2352x1568px. CFP. 45° field of view.
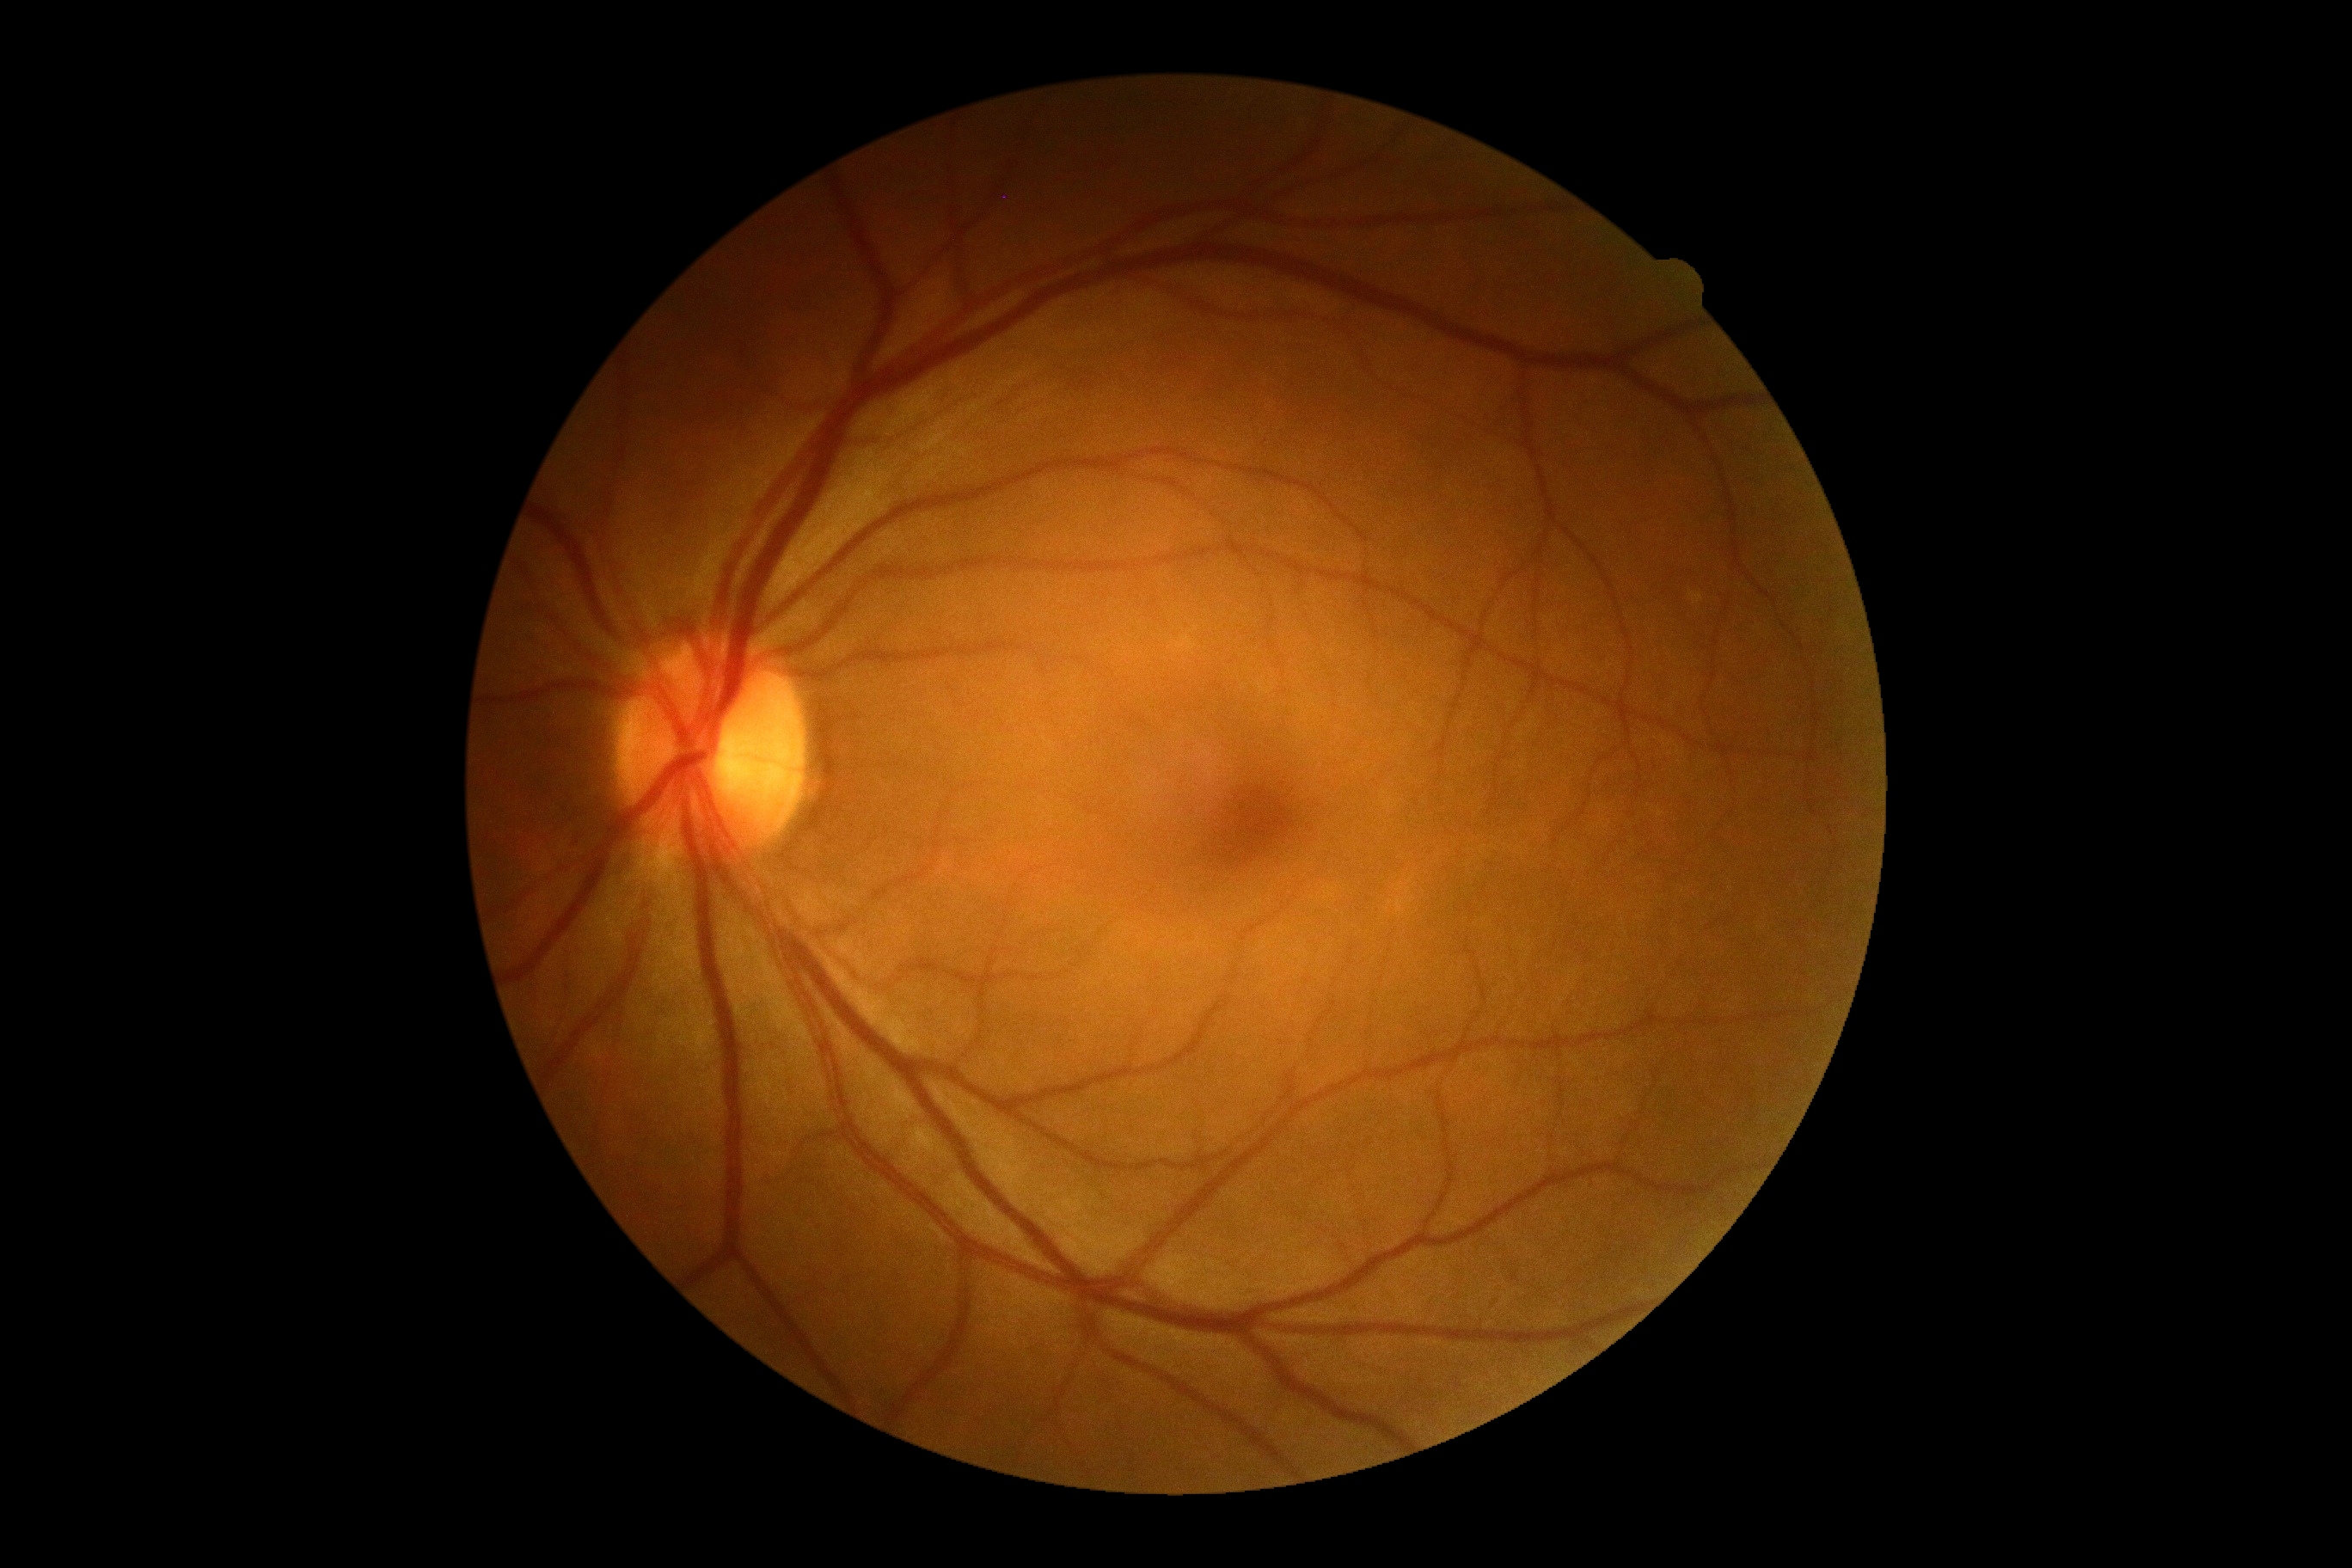

No DR findings.
DR severity: no apparent retinopathy (grade 0) — no visible signs of diabetic retinopathy.